45-degree field of view: 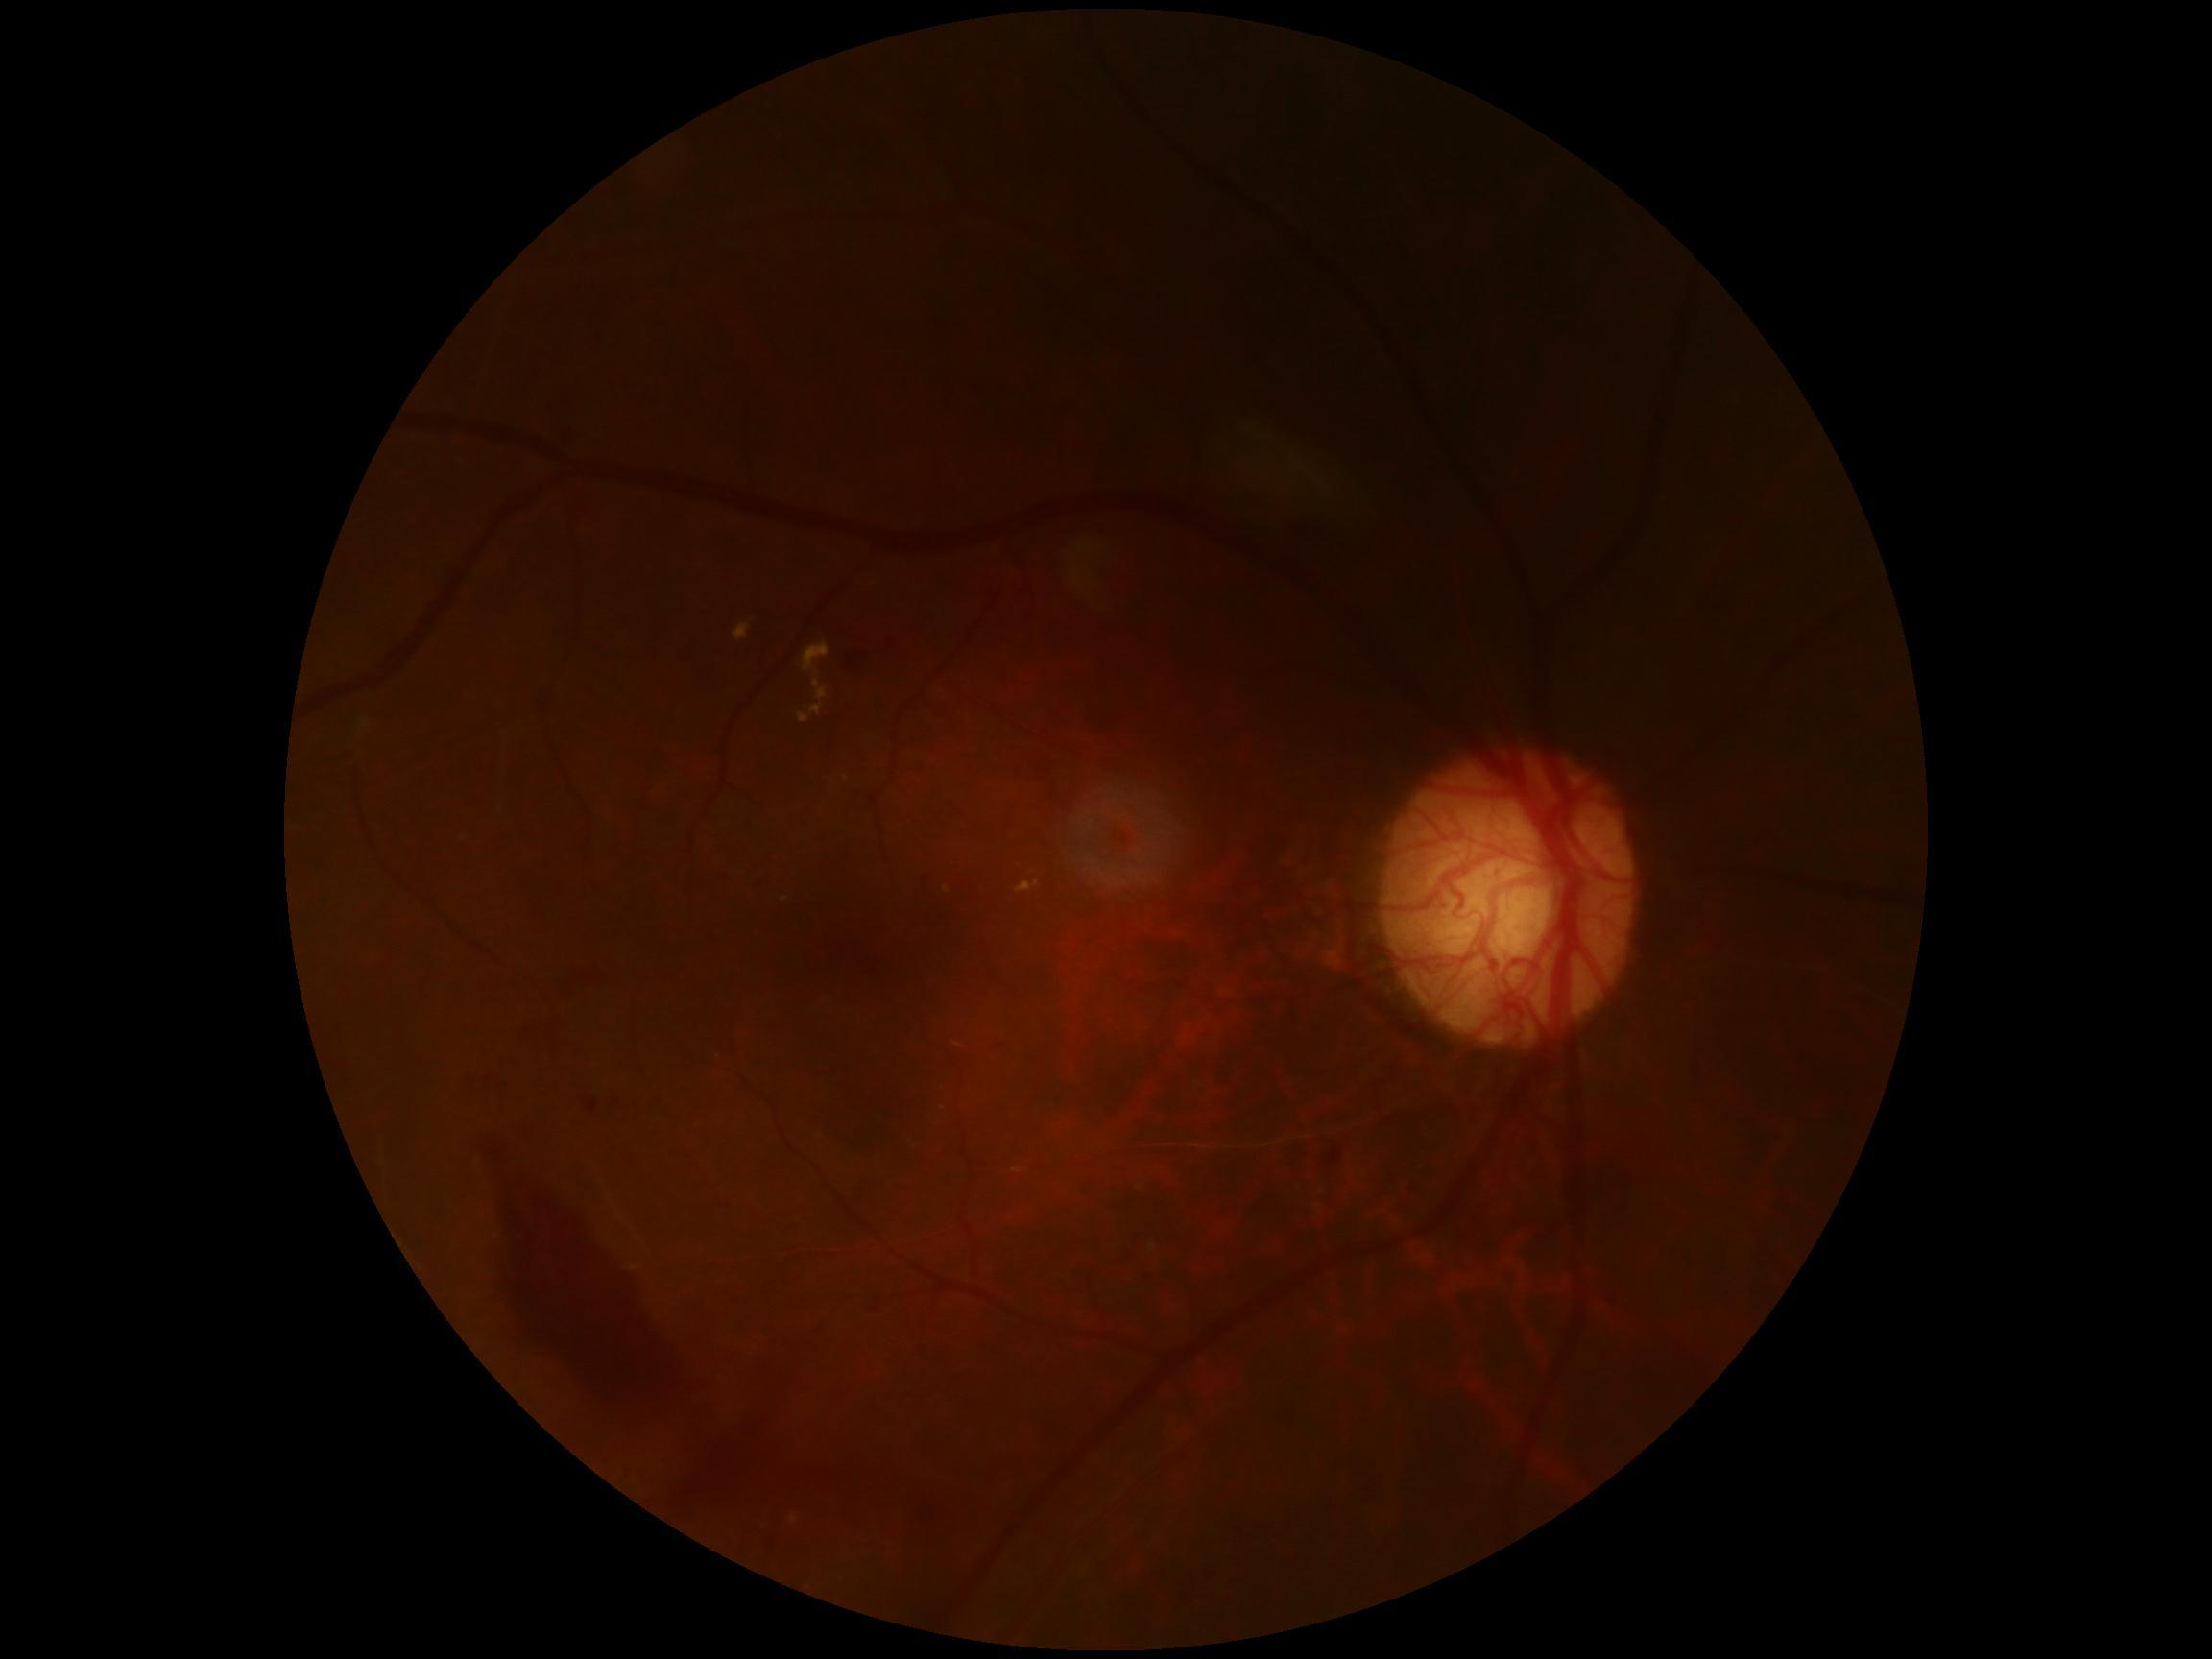   dr_grade: grade 4 (PDR)